Image size 1470x1137 · retinal fundus photograph — 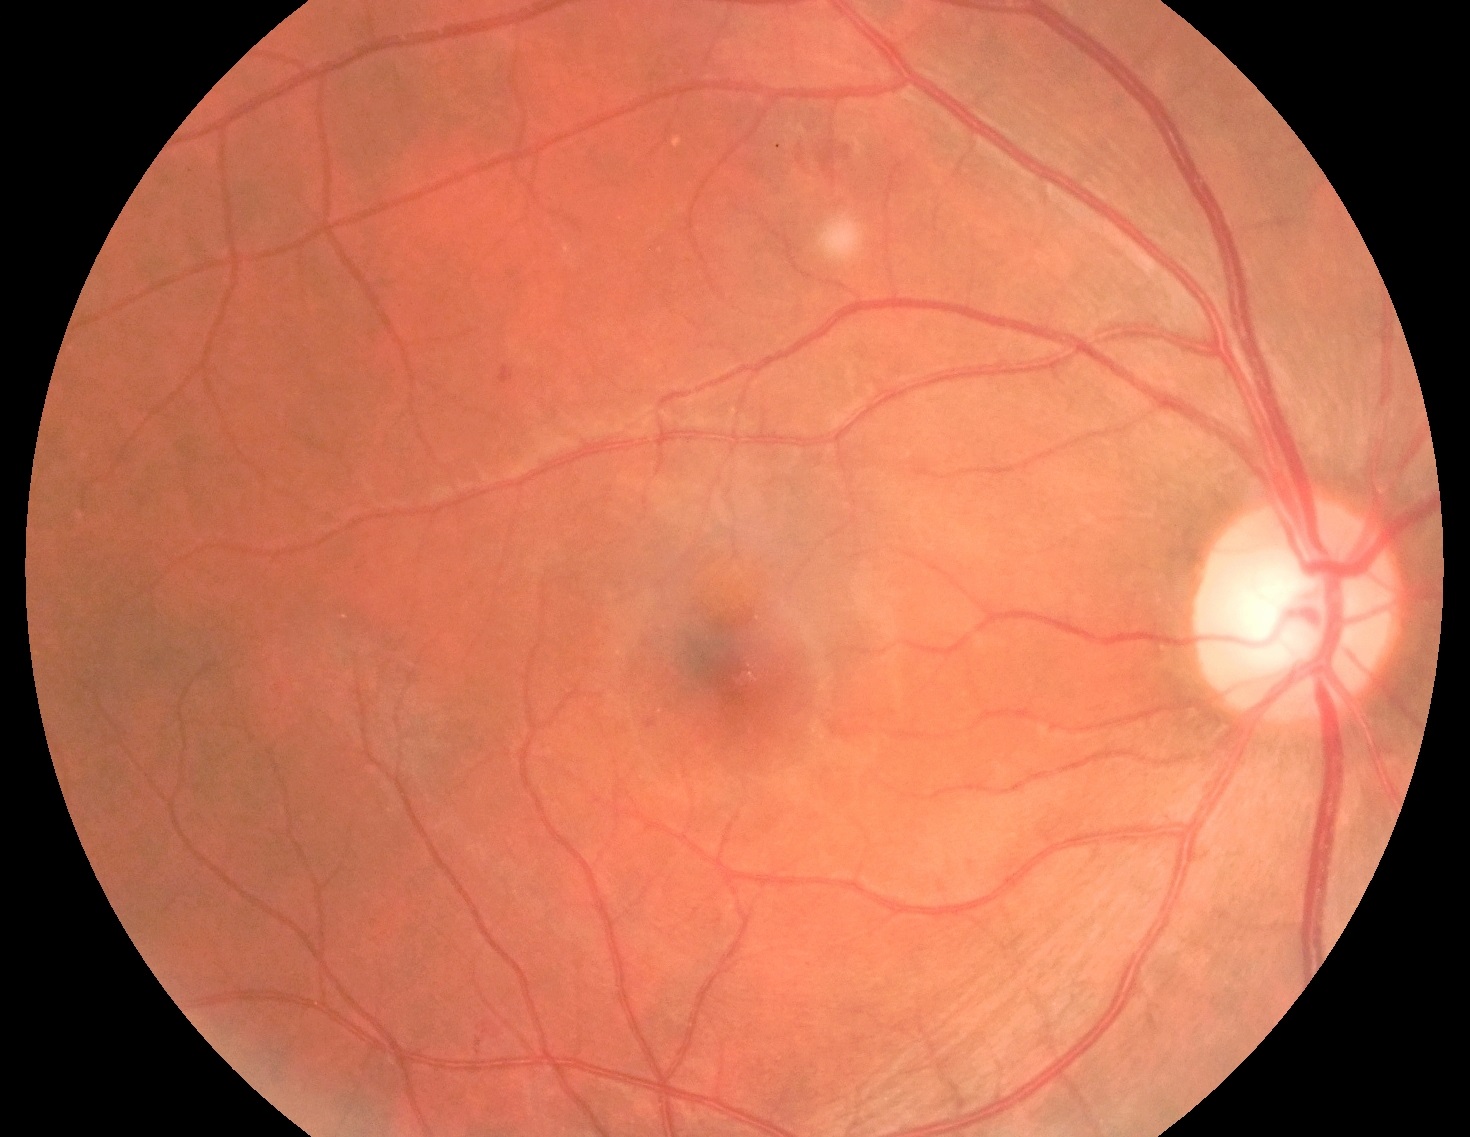
DR: 2/4.